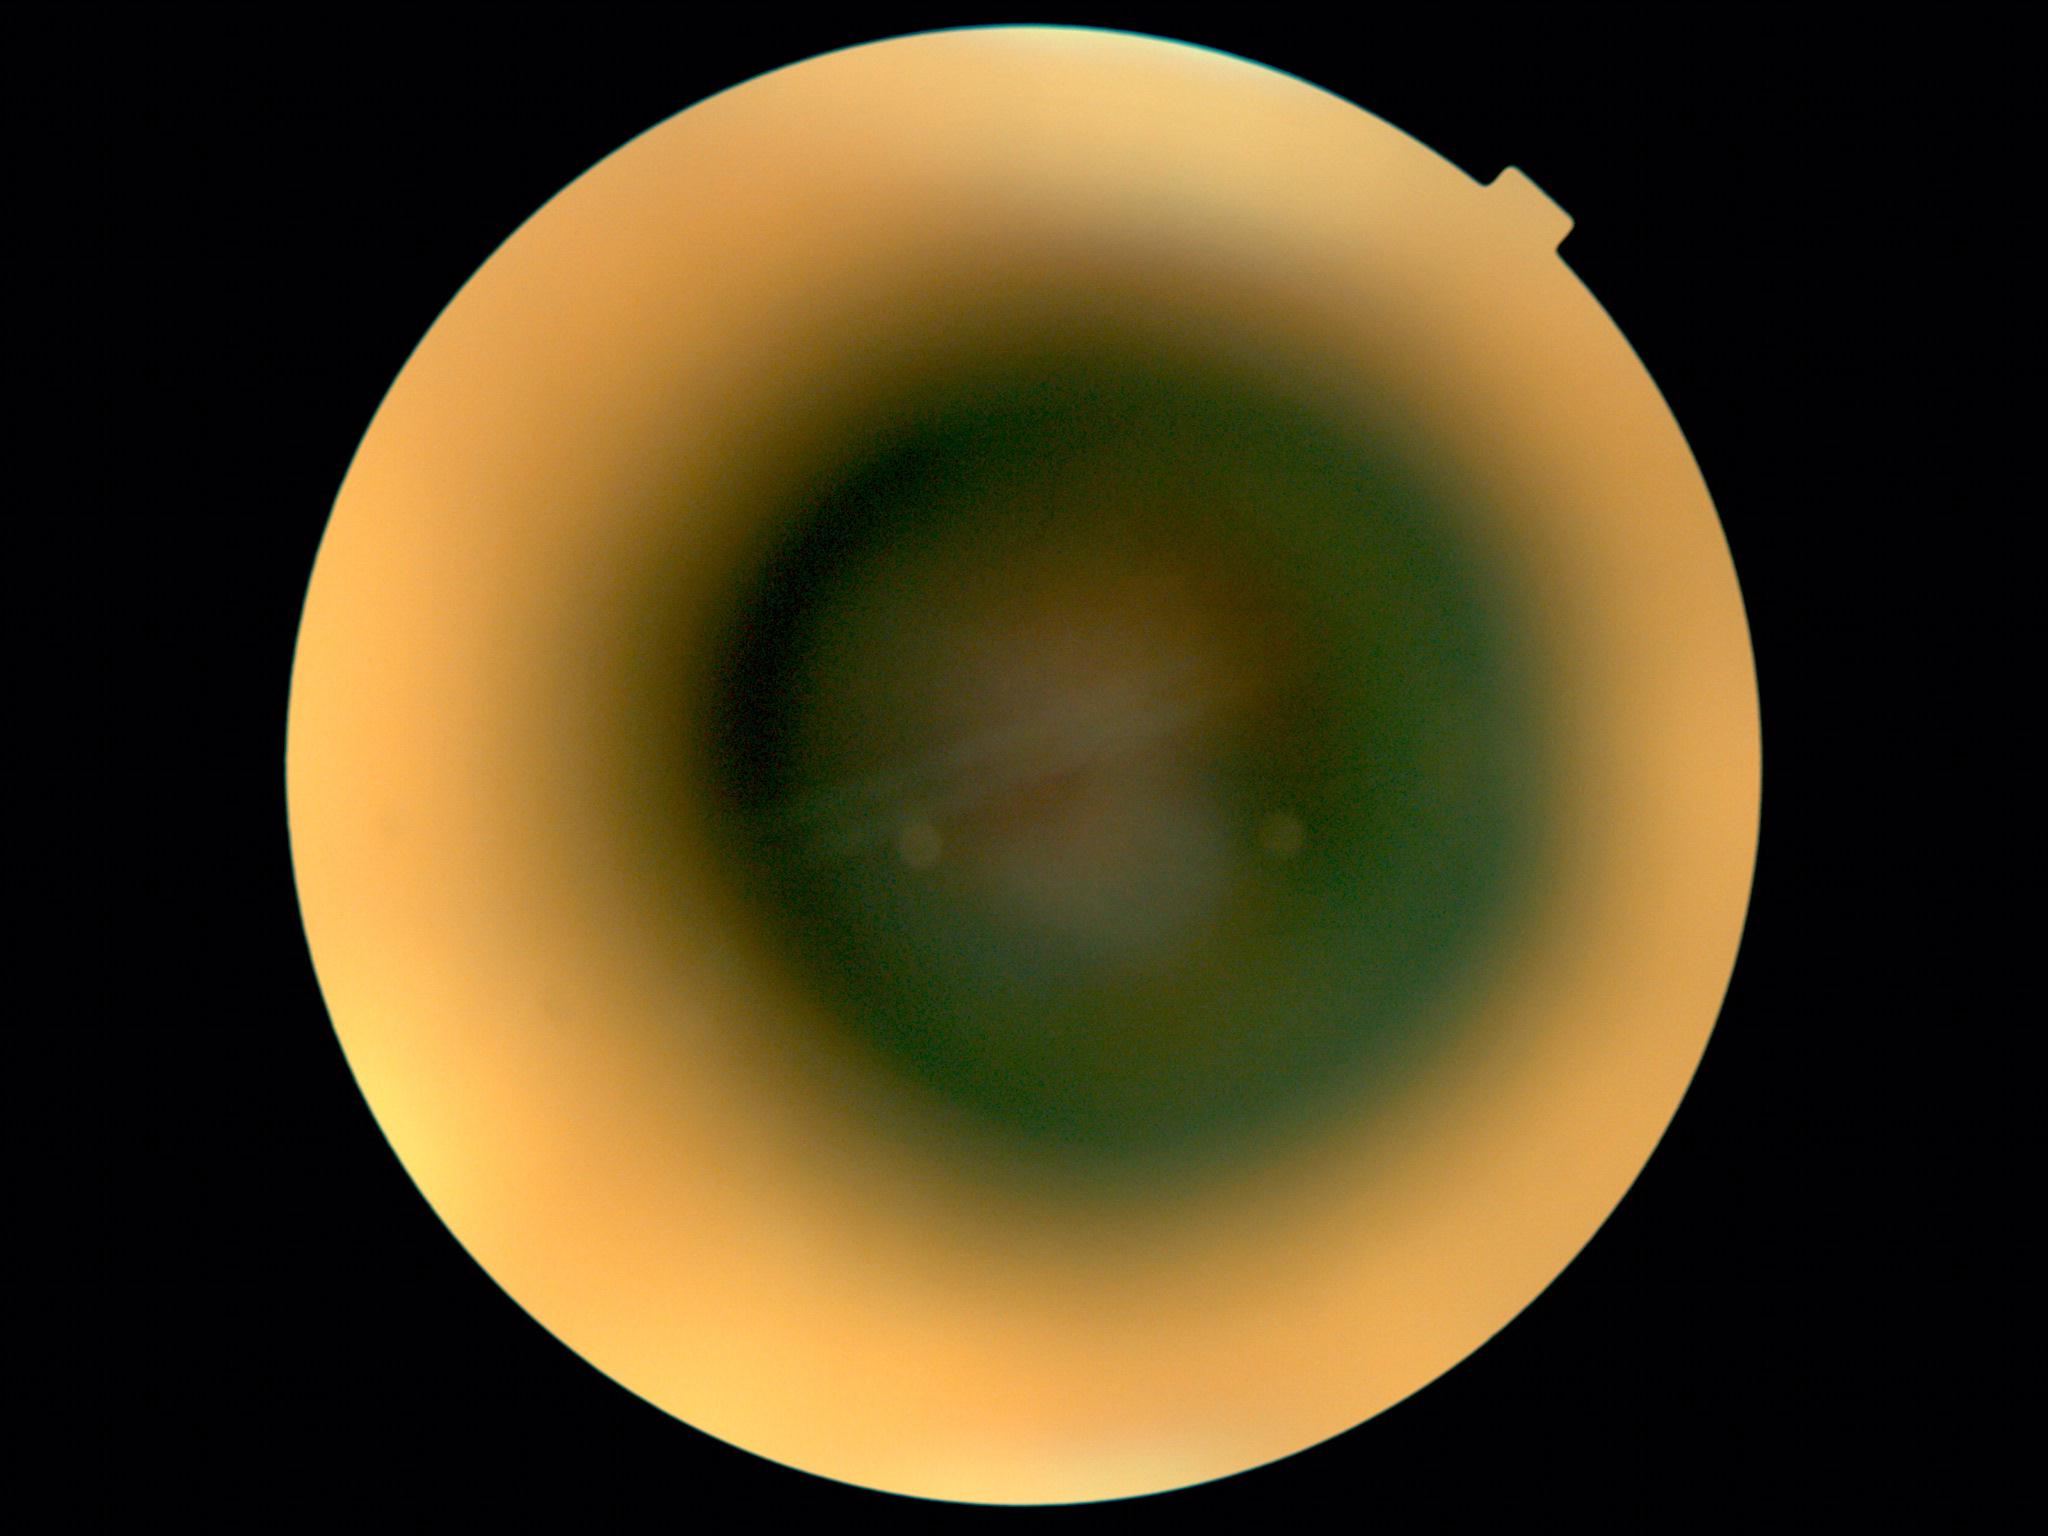 Image quality is insufficient for diabetic retinopathy assessment.
DR grade is ungradable.